Ultra-widefield fundus mosaic.
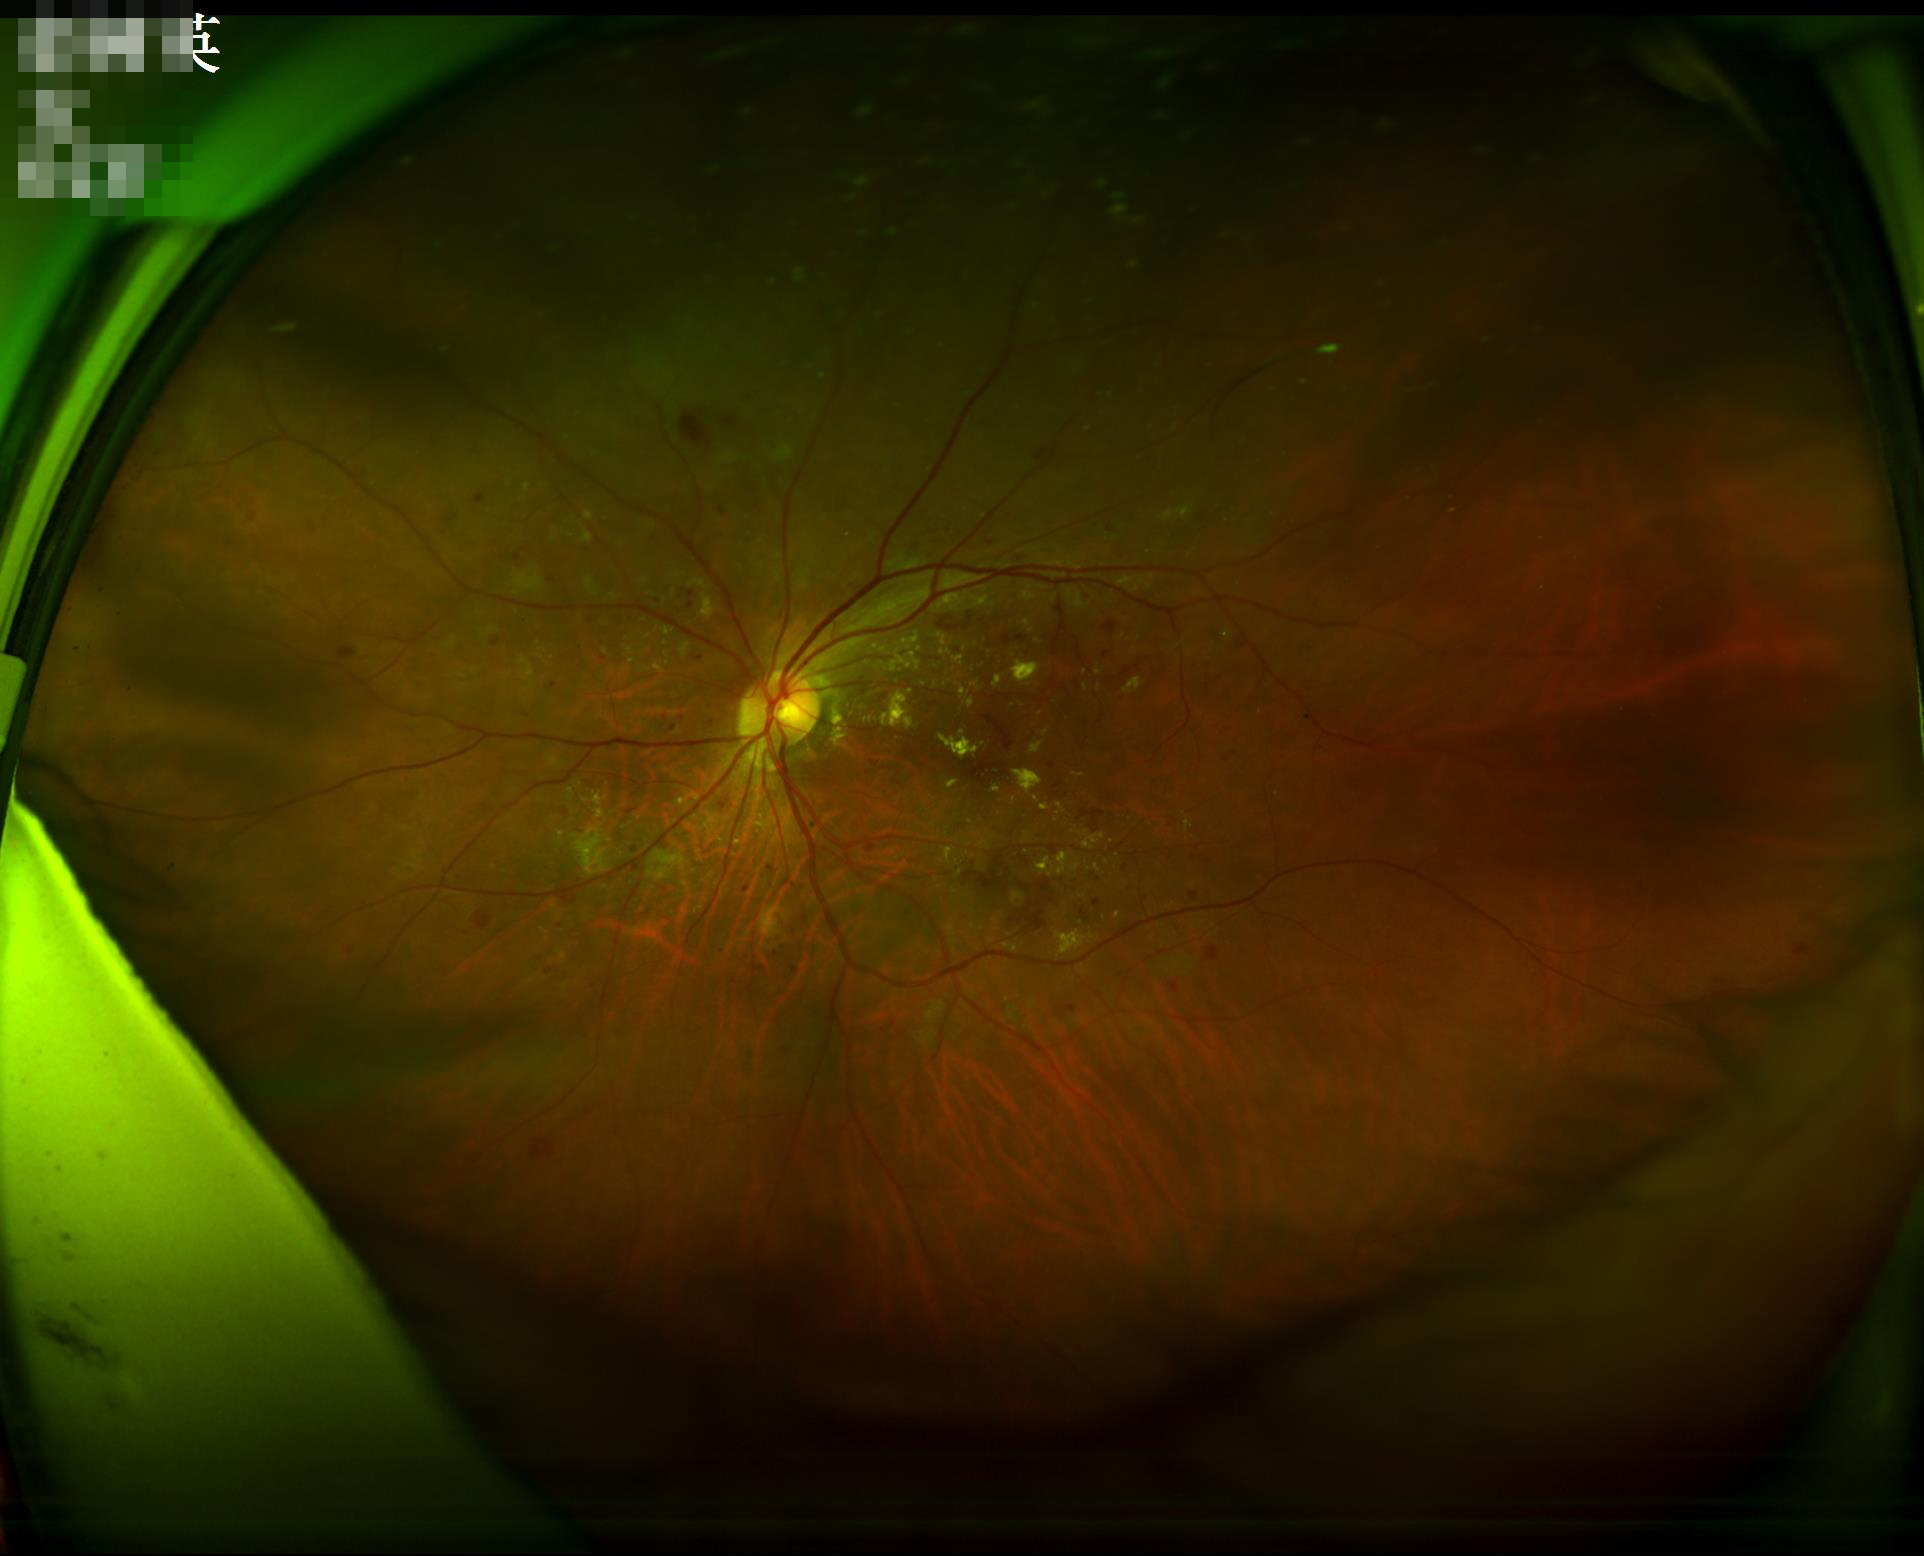 Sharpness: good; Overall: adequate; Contrast: good; Illumination: adequate.